Ultra-widefield fundus photograph; 1924x1556px:
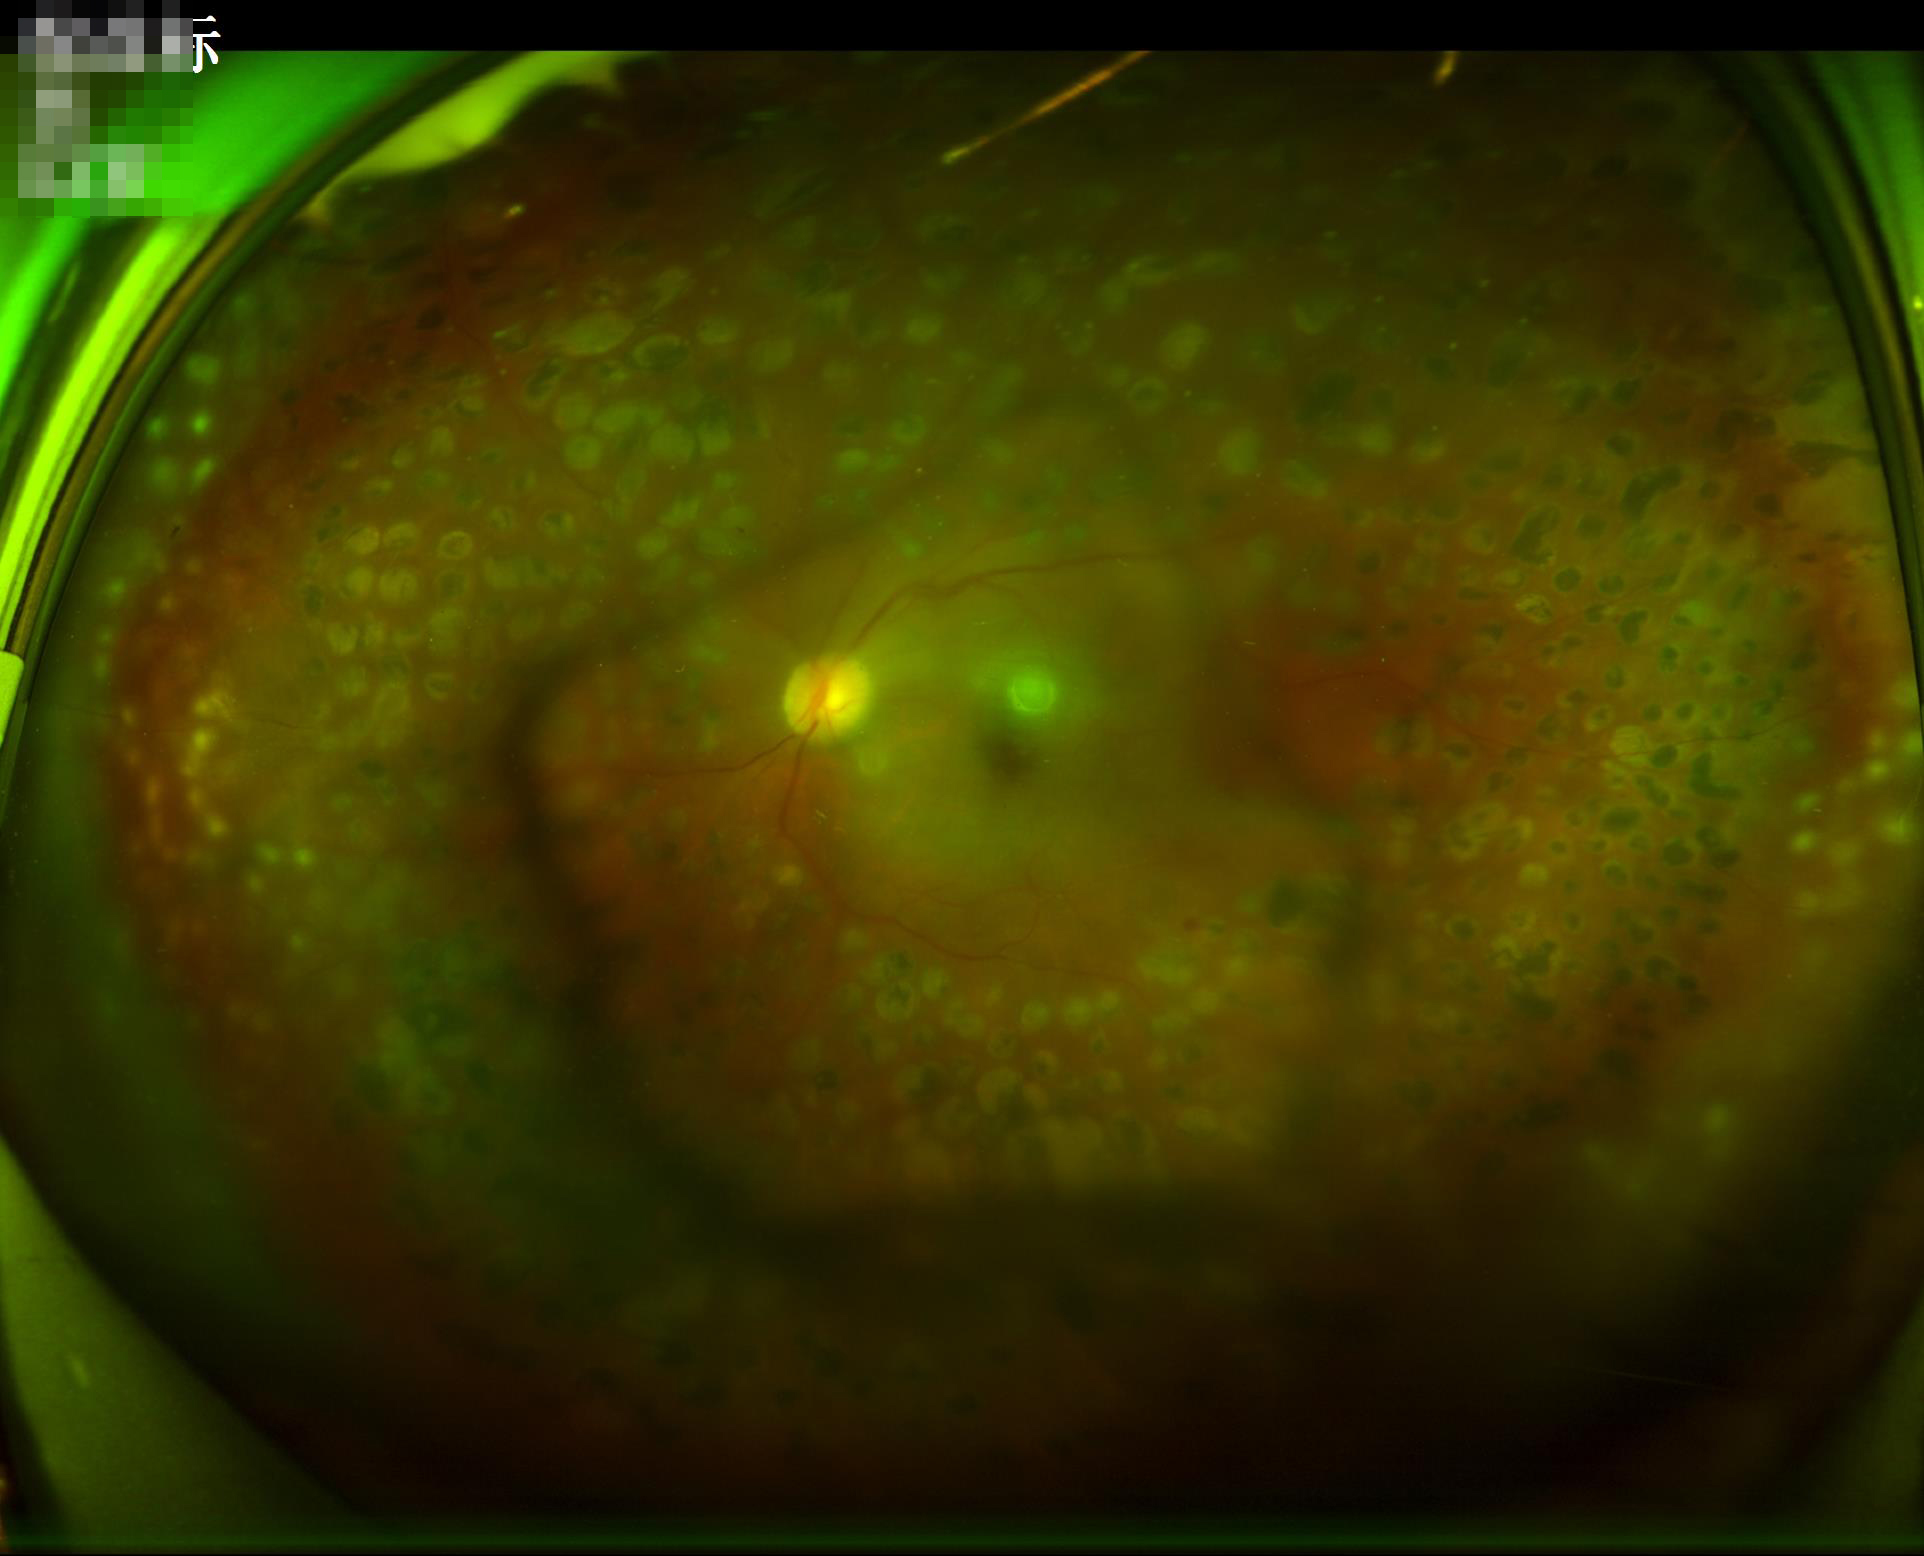 Illumination/color: suboptimal; Overall image quality: suboptimal; Contrast: good; Clarity: out of focus.